Wide-field fundus photograph of an infant — 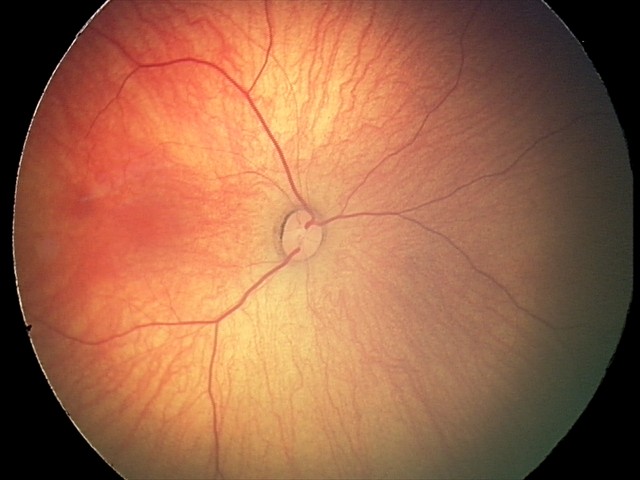

From an examination with diagnosis of retinal hemorrhages.